Nonmydriatic · camera: NIDEK AFC-230 — 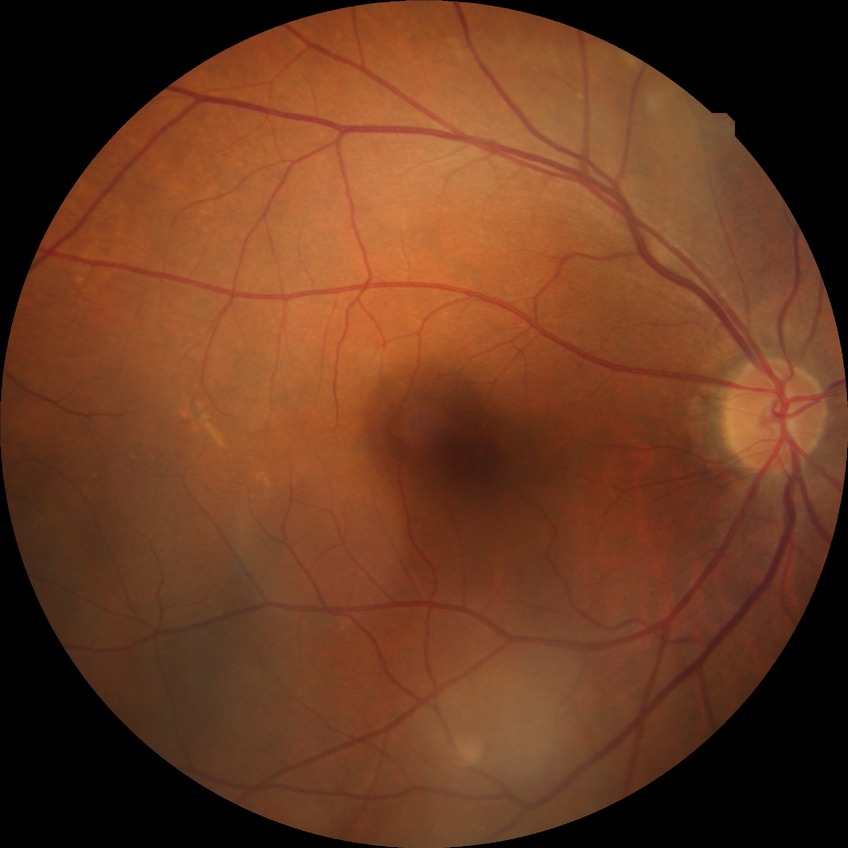 Diabetic retinopathy (DR) is NDR (no diabetic retinopathy).